Davis DR grading · without pupil dilation · color fundus image
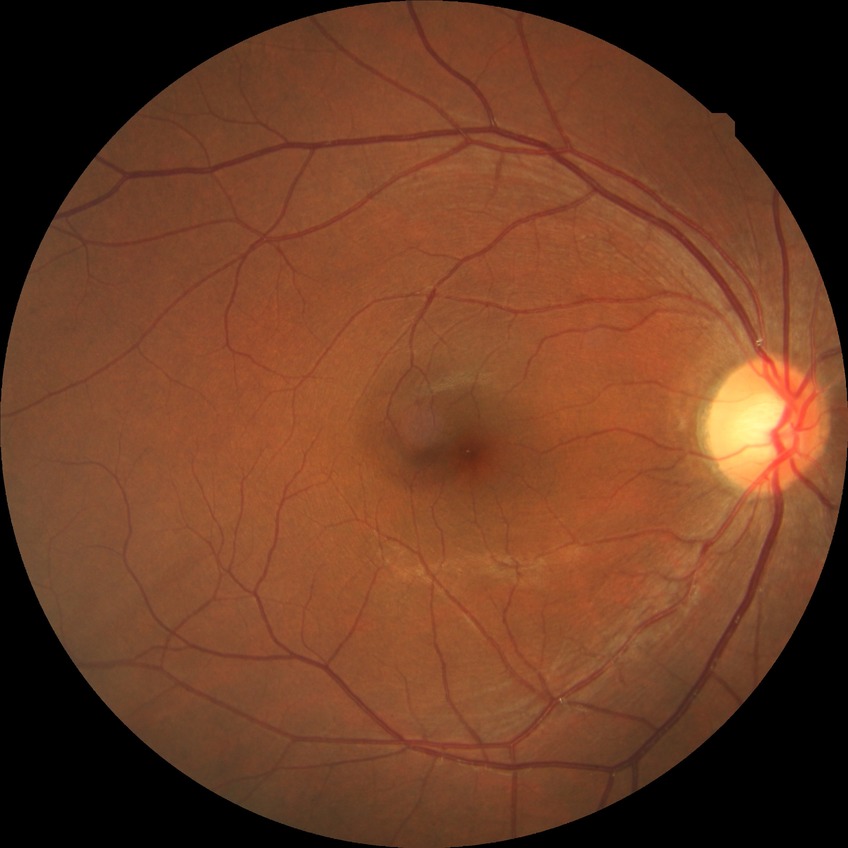 DR grade: NDR.